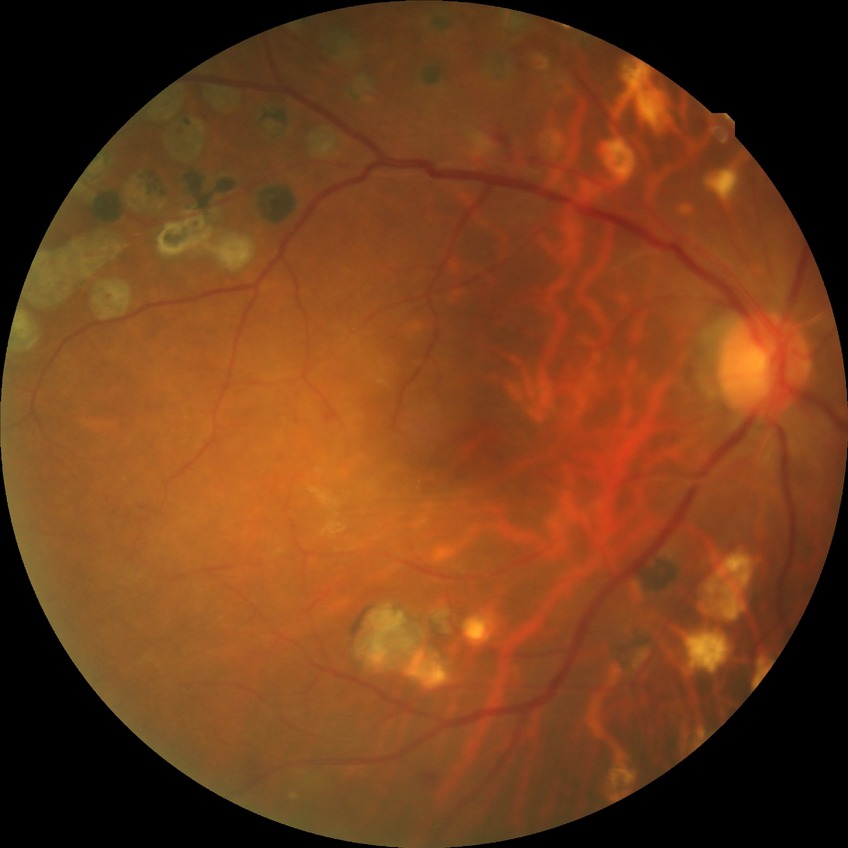

  davis_grade: simple diabetic retinopathy